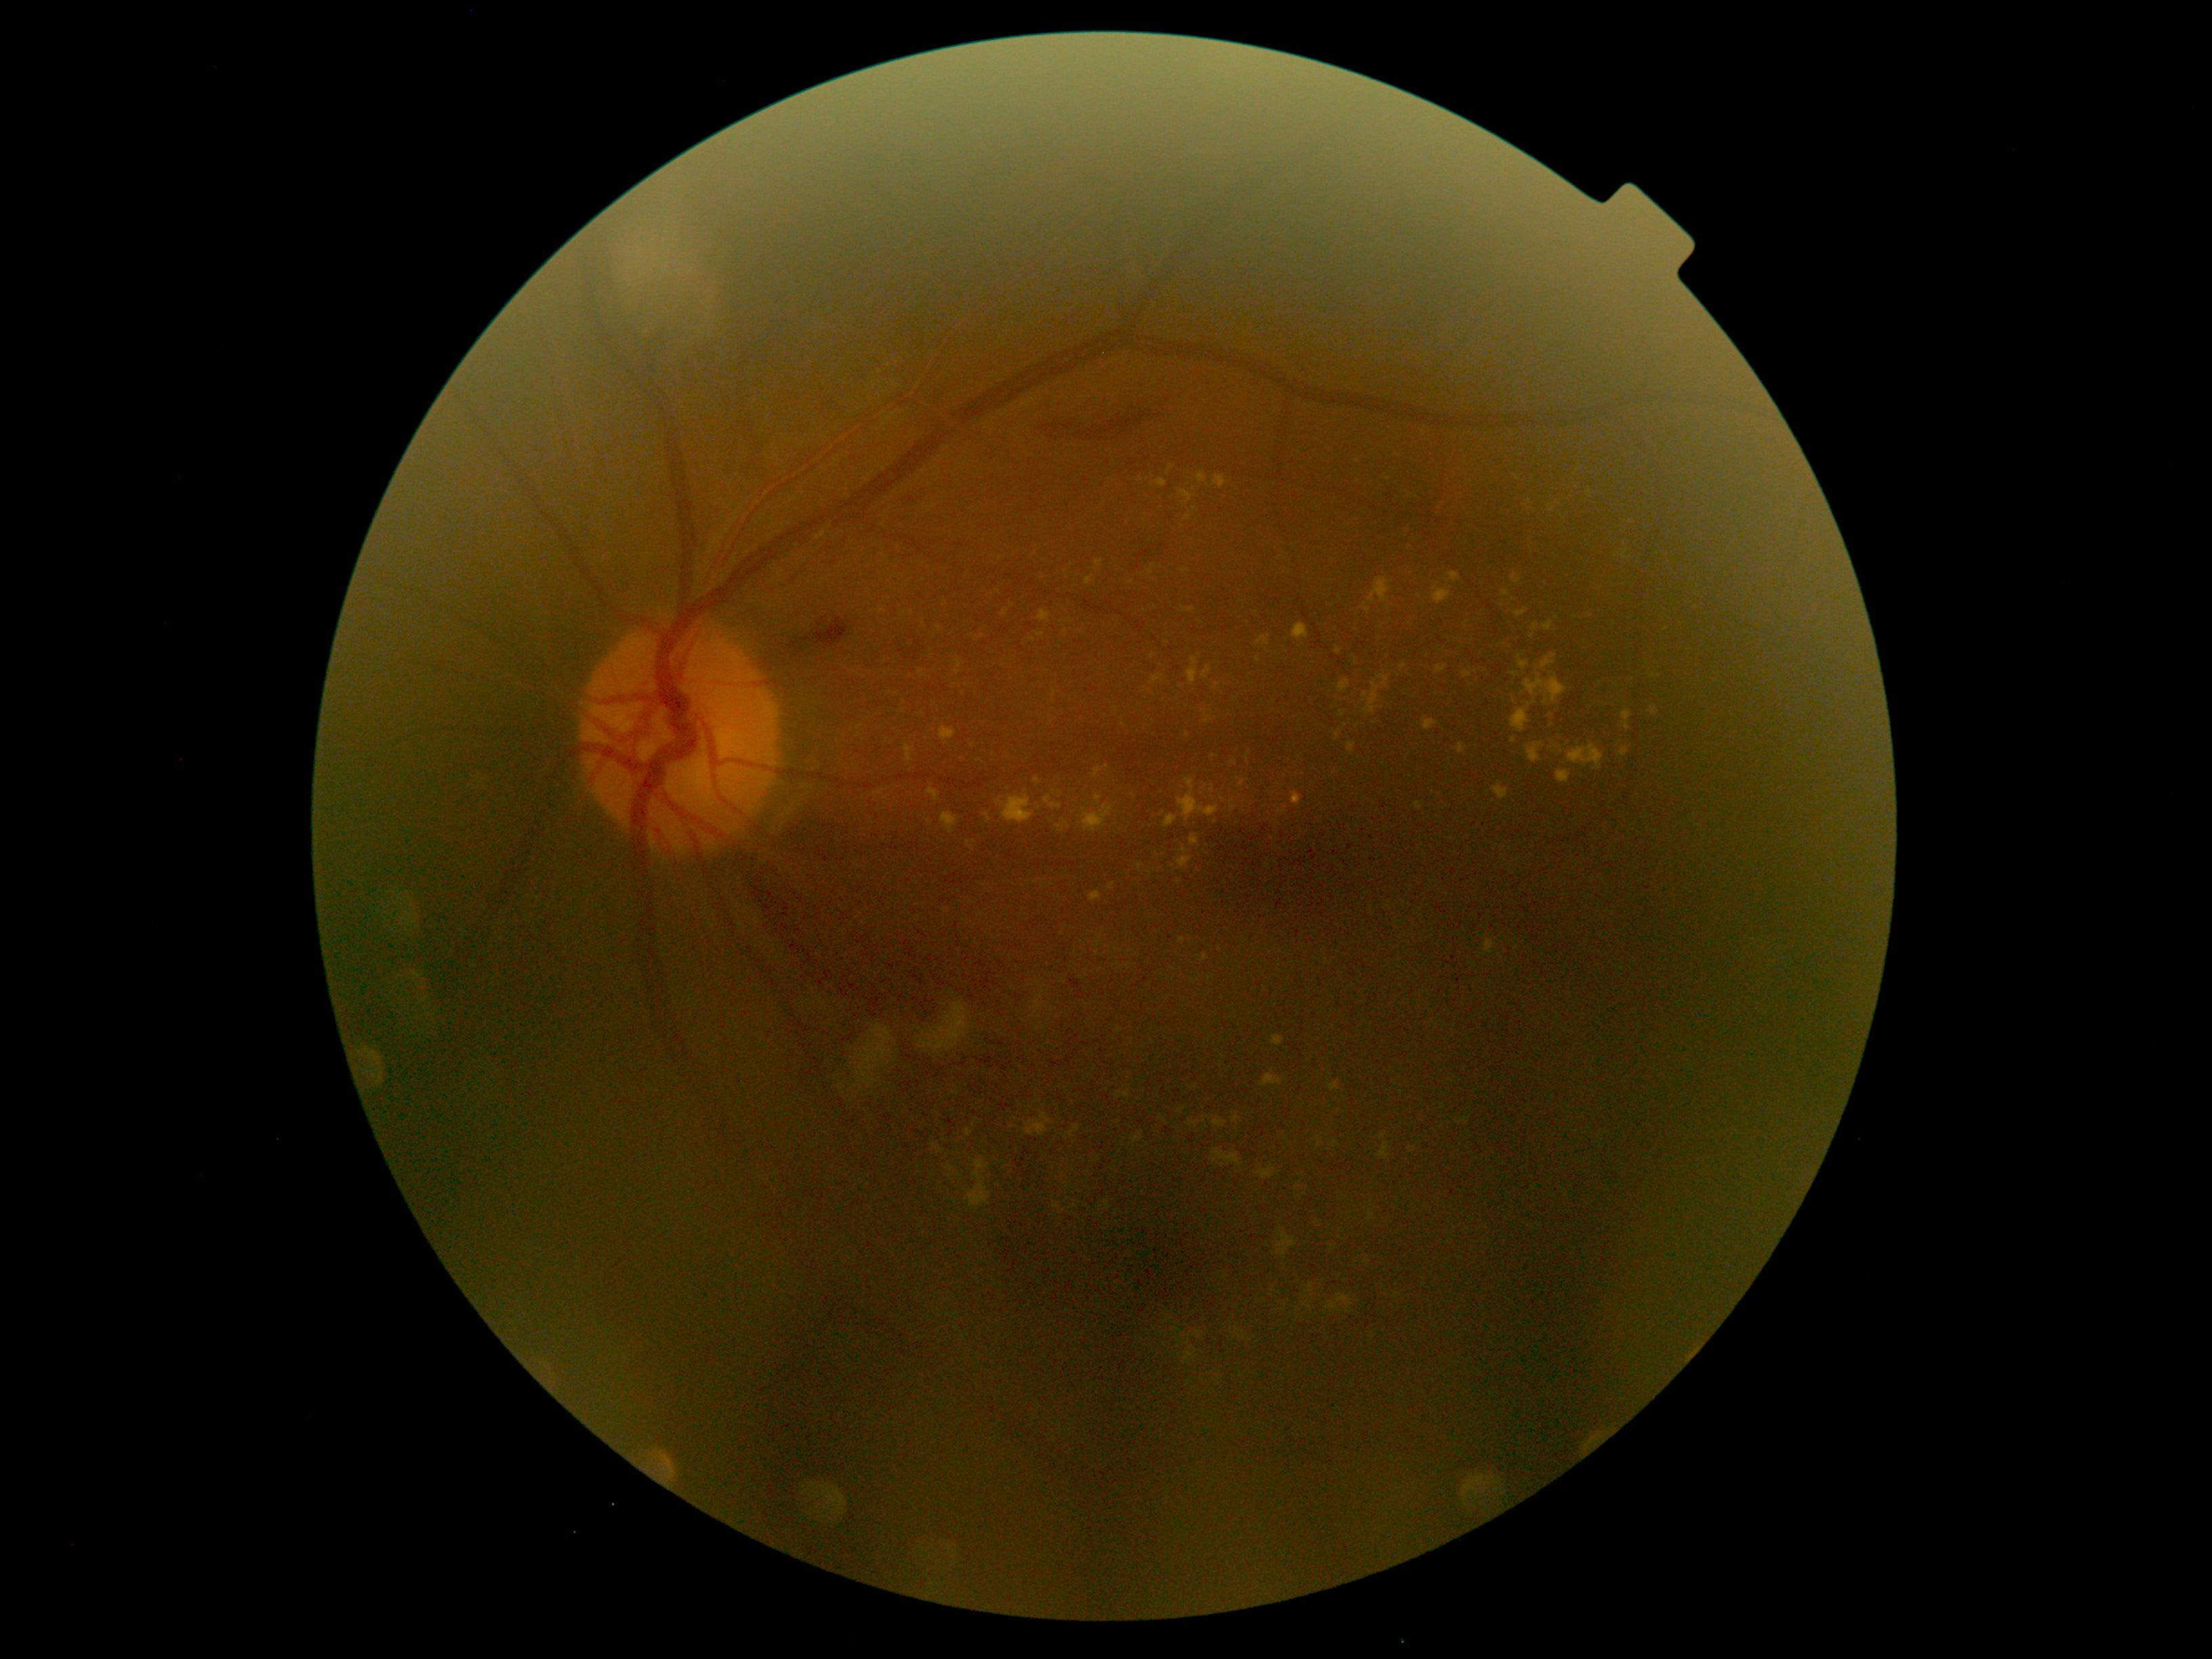
Diabetic retinopathy (DR): grade 2 (moderate NPDR).